Wide-field contact fundus photograph of an infant — 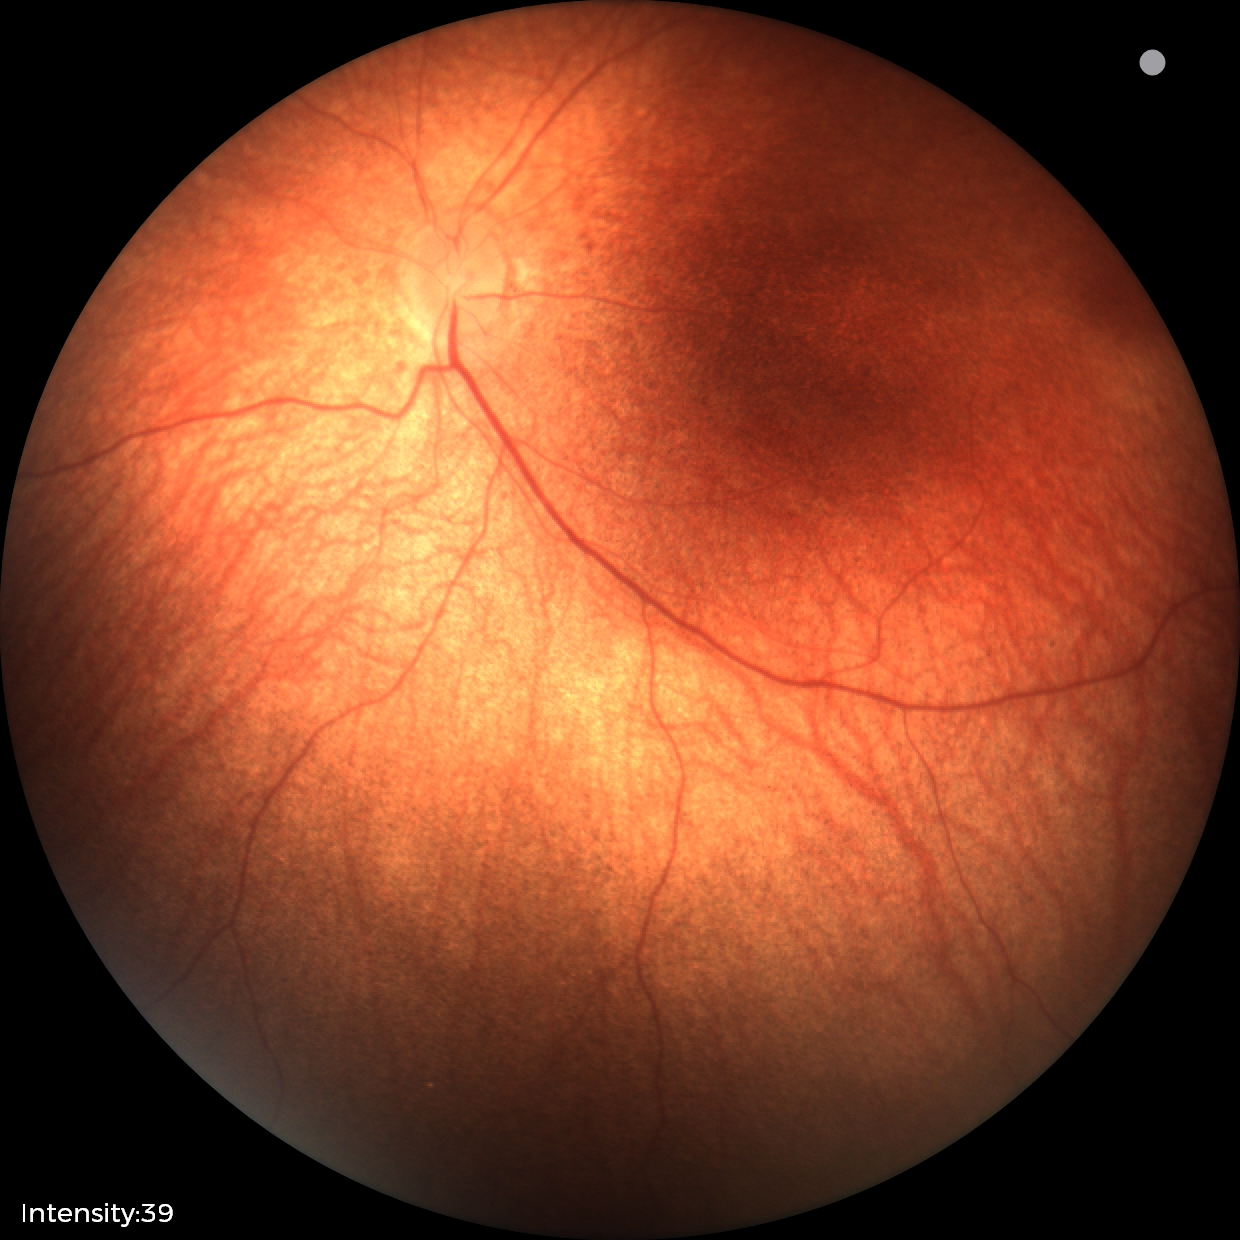

Physiological retinal appearance for postconceptual age.